Field includes the optic disc and macula
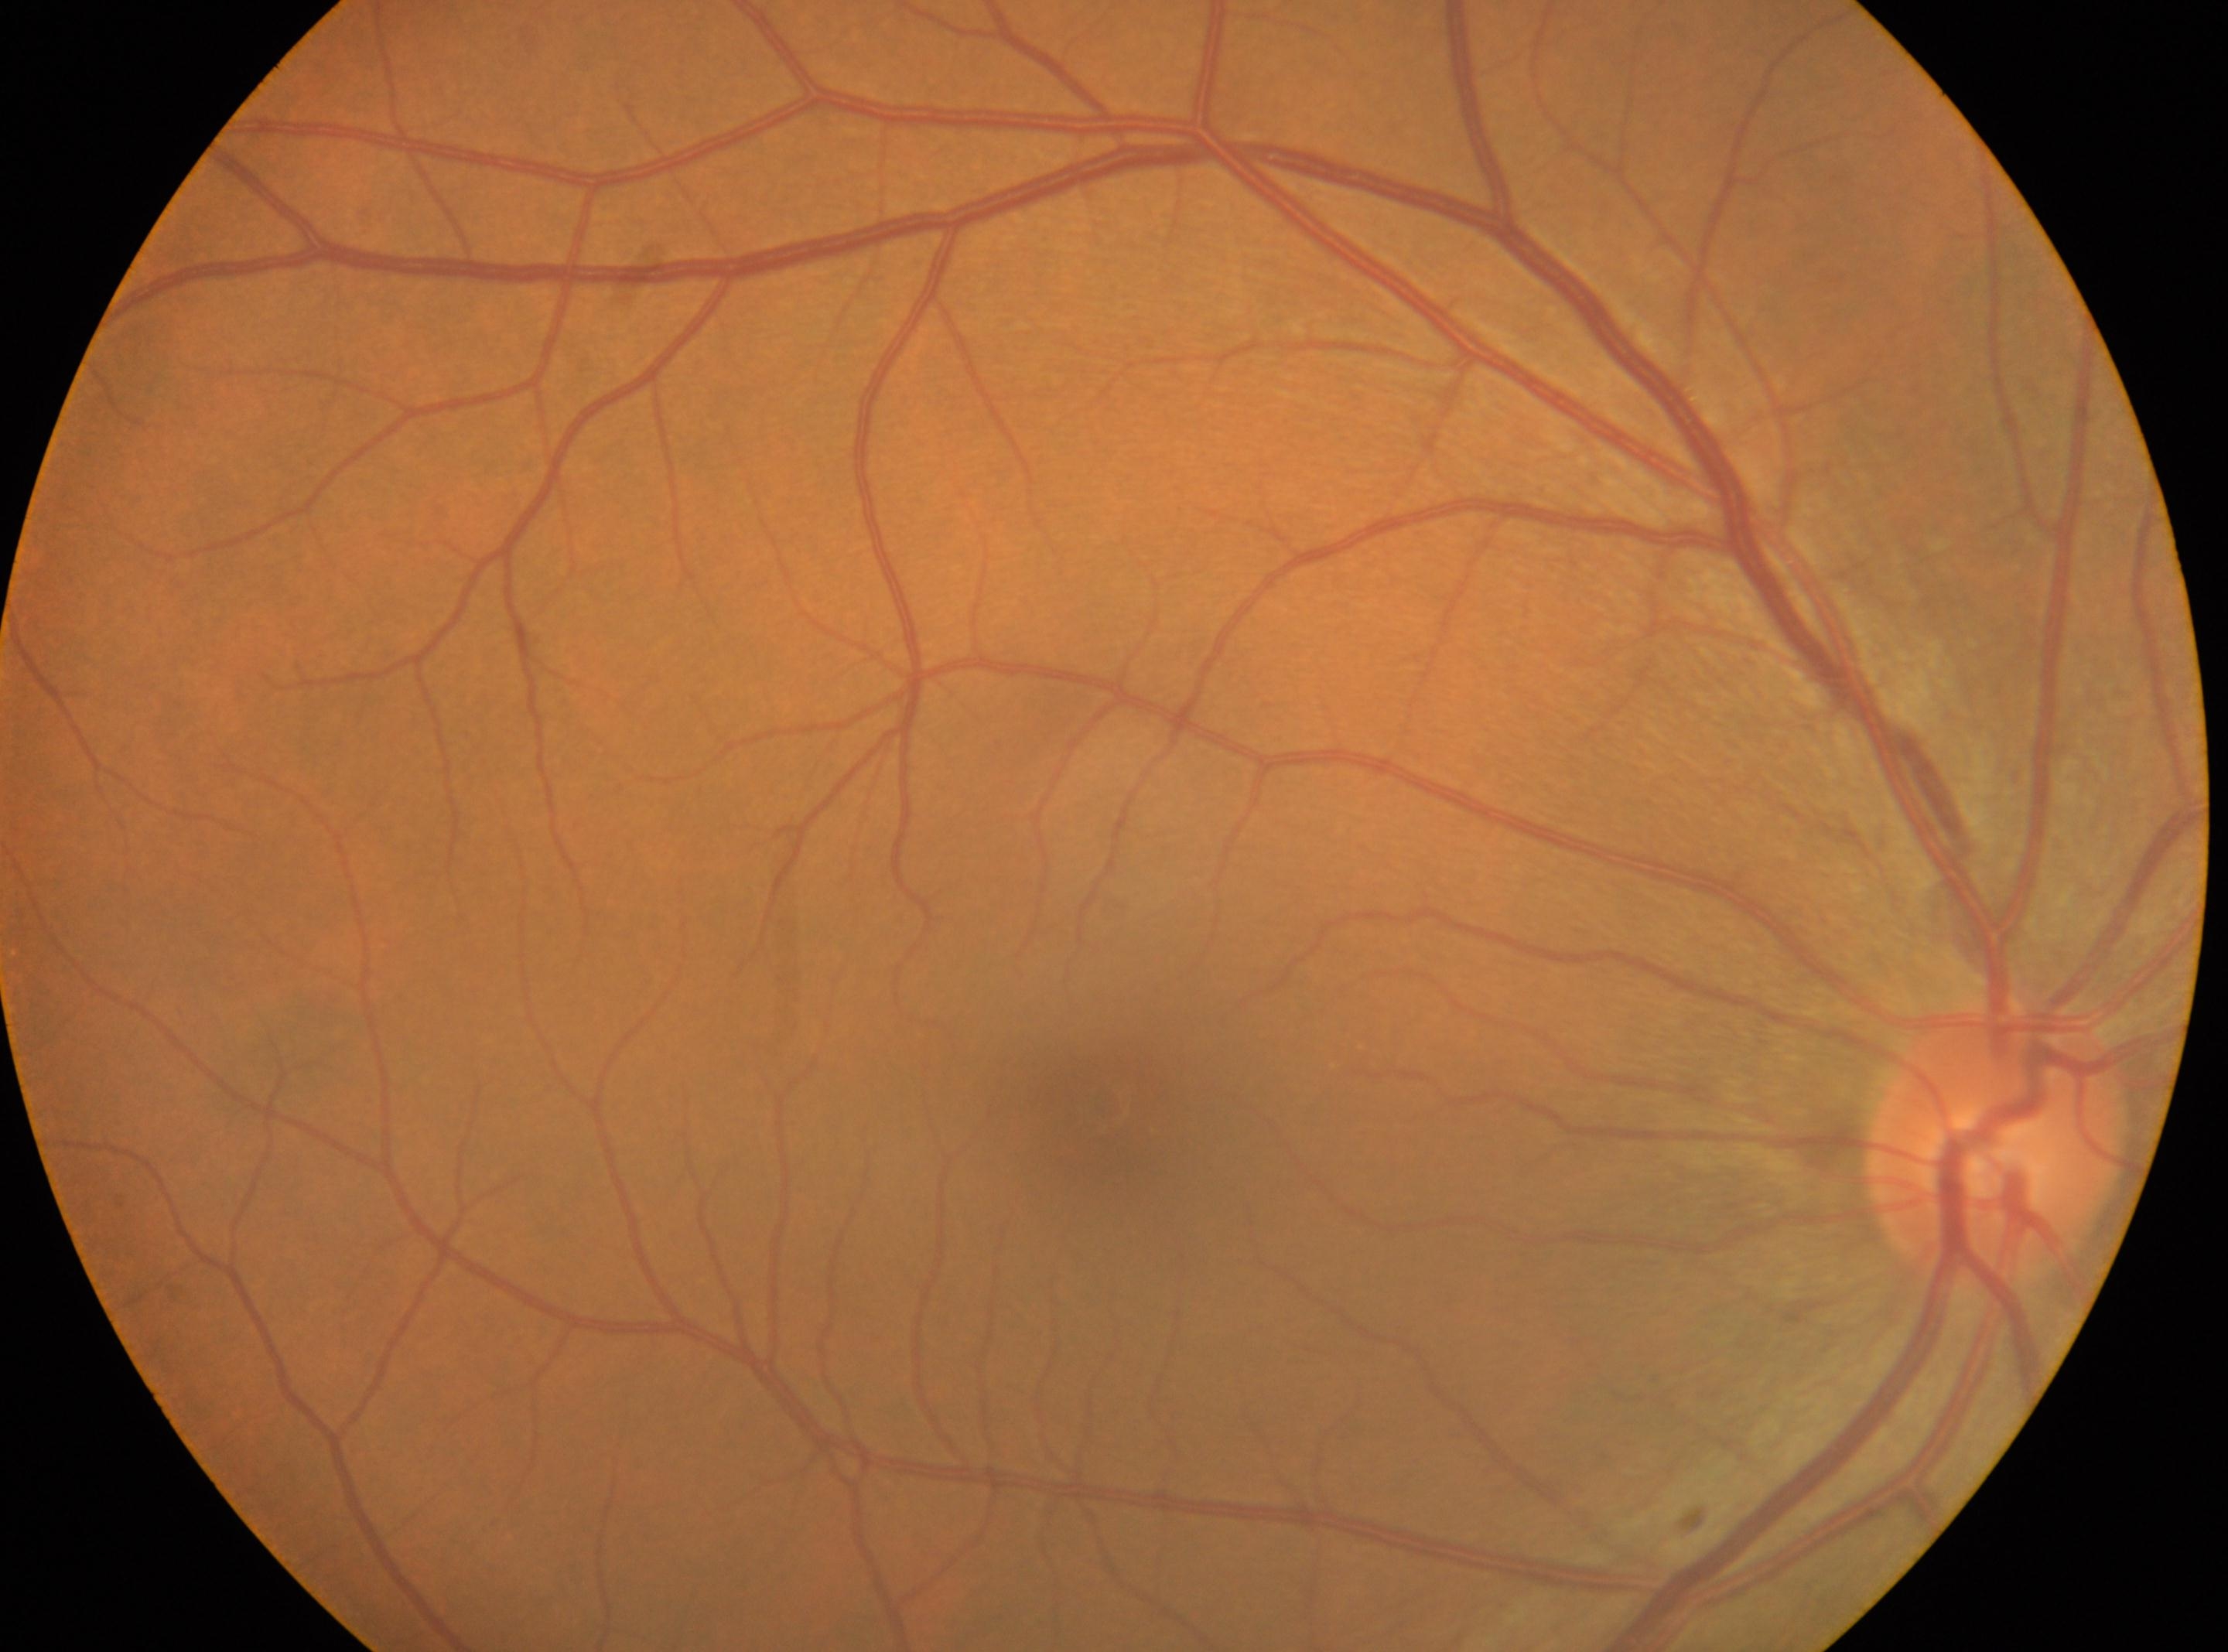 DR severity@no apparent retinopathy (grade 0) — no visible signs of diabetic retinopathy
the optic disc@(x: 1997, y: 1142)
macular center@(x: 1108, y: 1114)
No DR findings
oculus dexter